Ultra-widefield (UWF) fundus image:
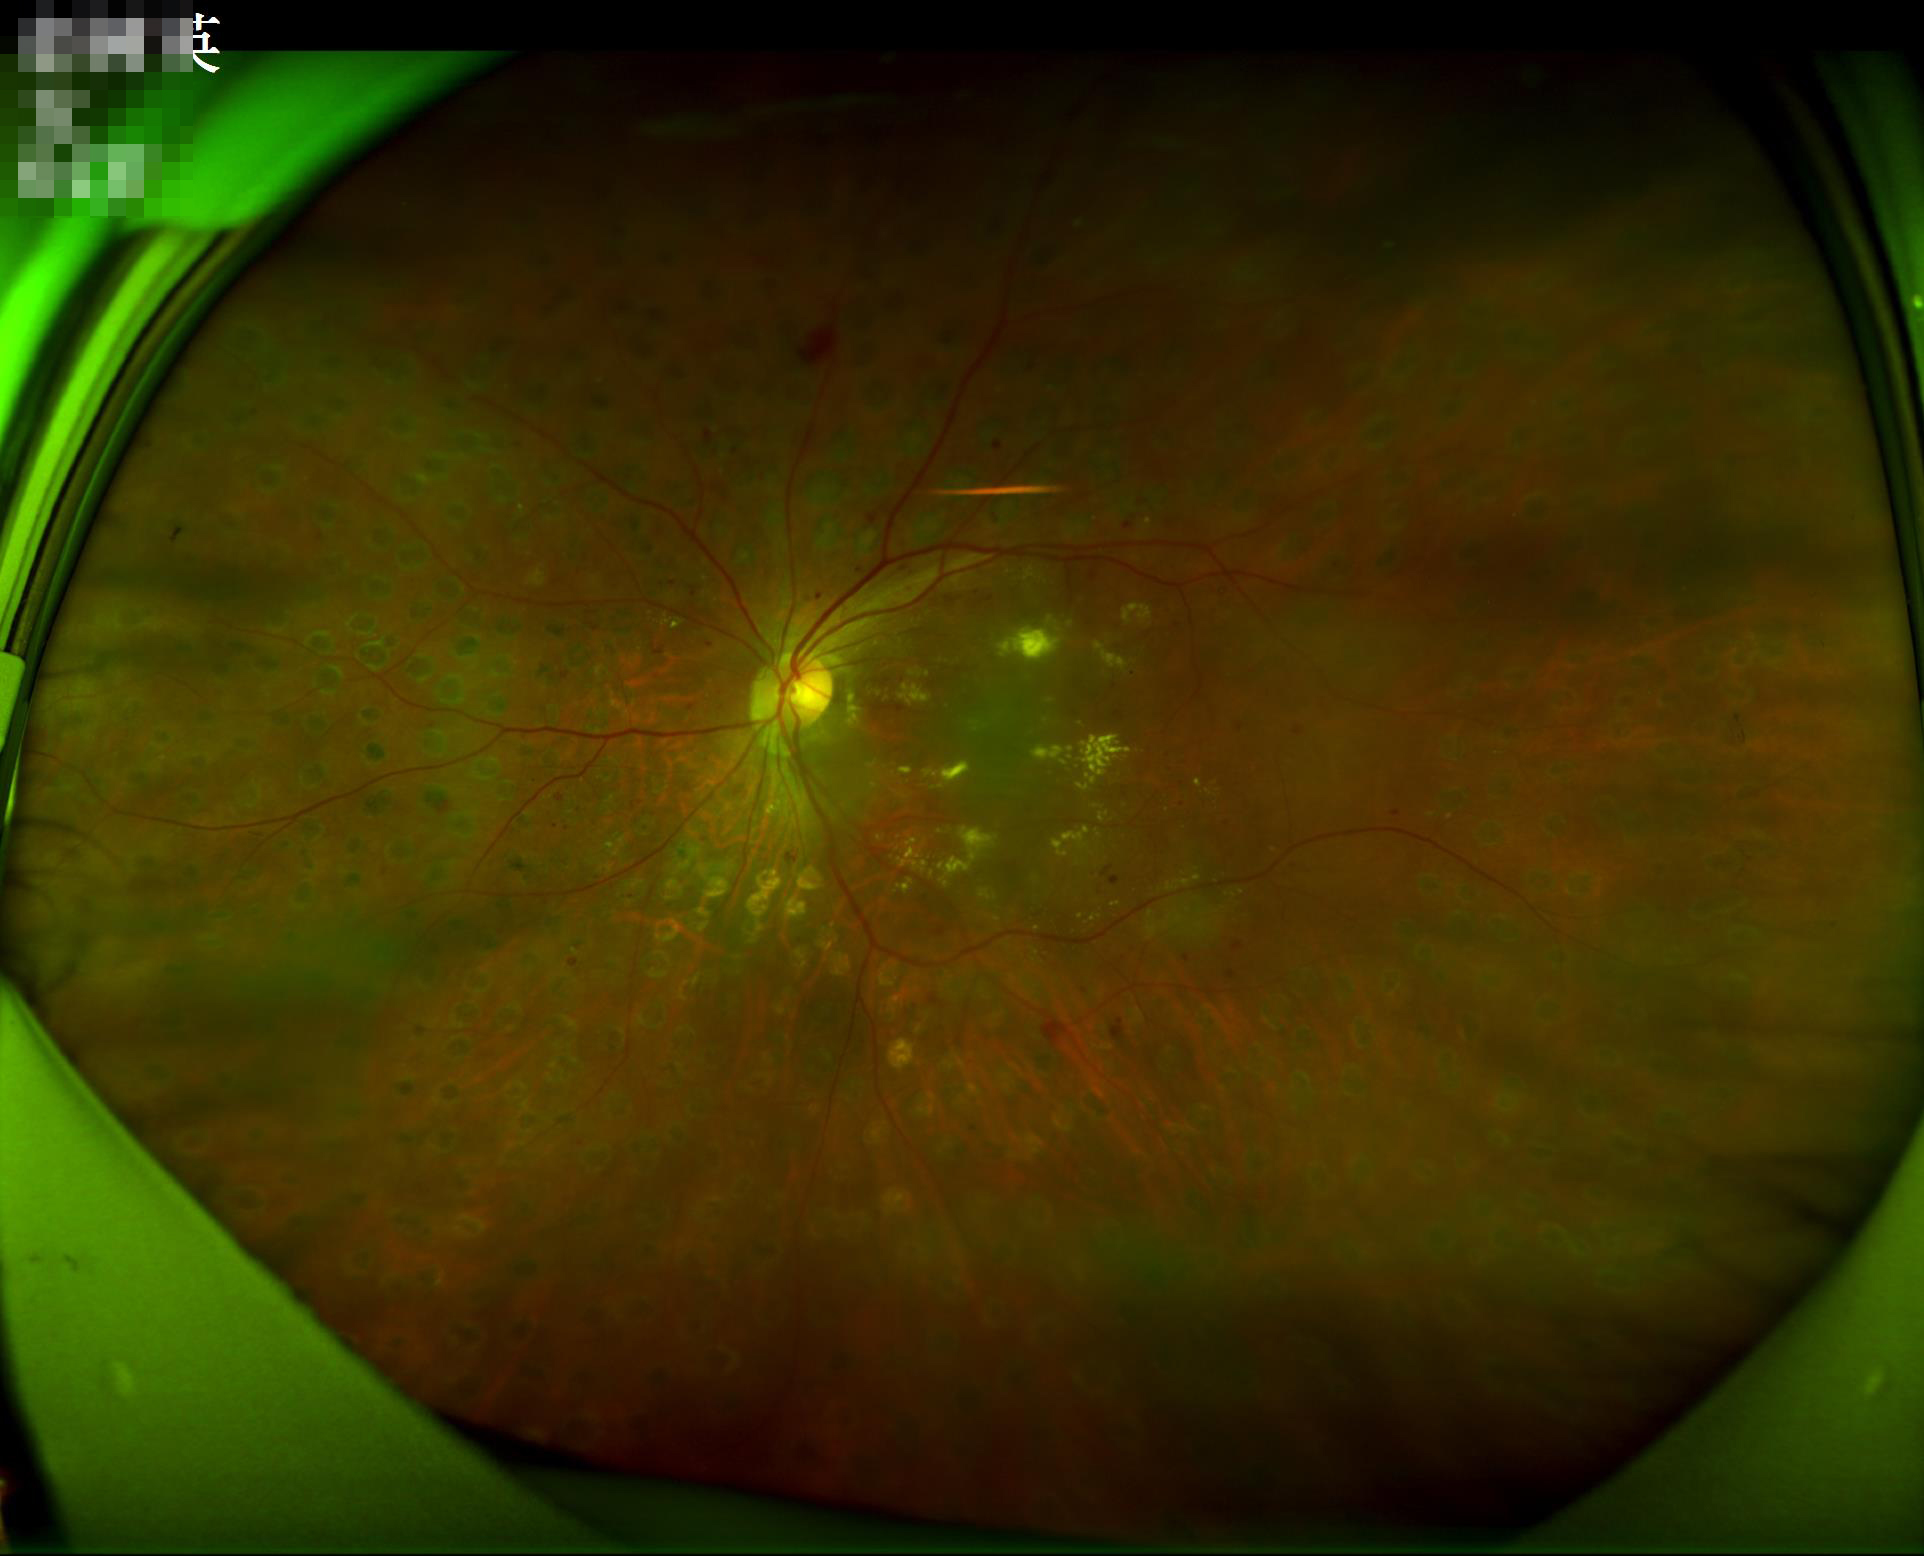
Acceptable image quality.
Illumination is uneven.
No noticeable blur.
Vessels and details are readily distinguishable.